848x848px · without pupil dilation · 45-degree field of view · NIDEK AFC-230 fundus camera · modified Davis classification · CFP — 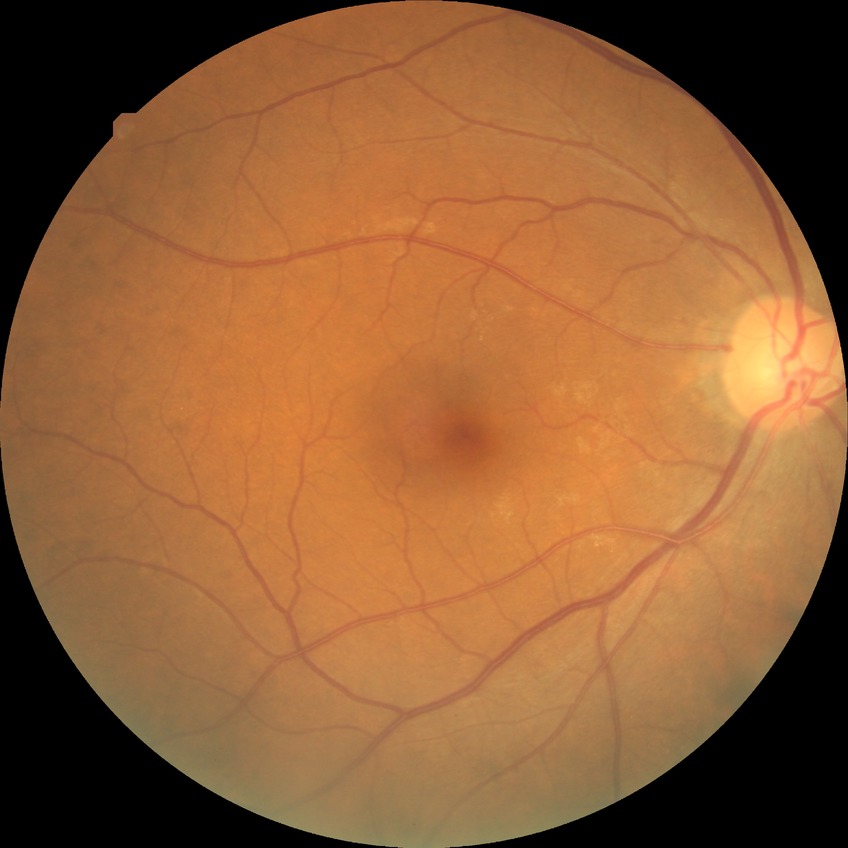
Diabetic retinopathy (DR): no diabetic retinopathy (NDR).